Topcon TRC-NW400; 2212 by 1661 pixels; retinal fundus photograph; sex: F; 30° field of view; optic disc-centered.
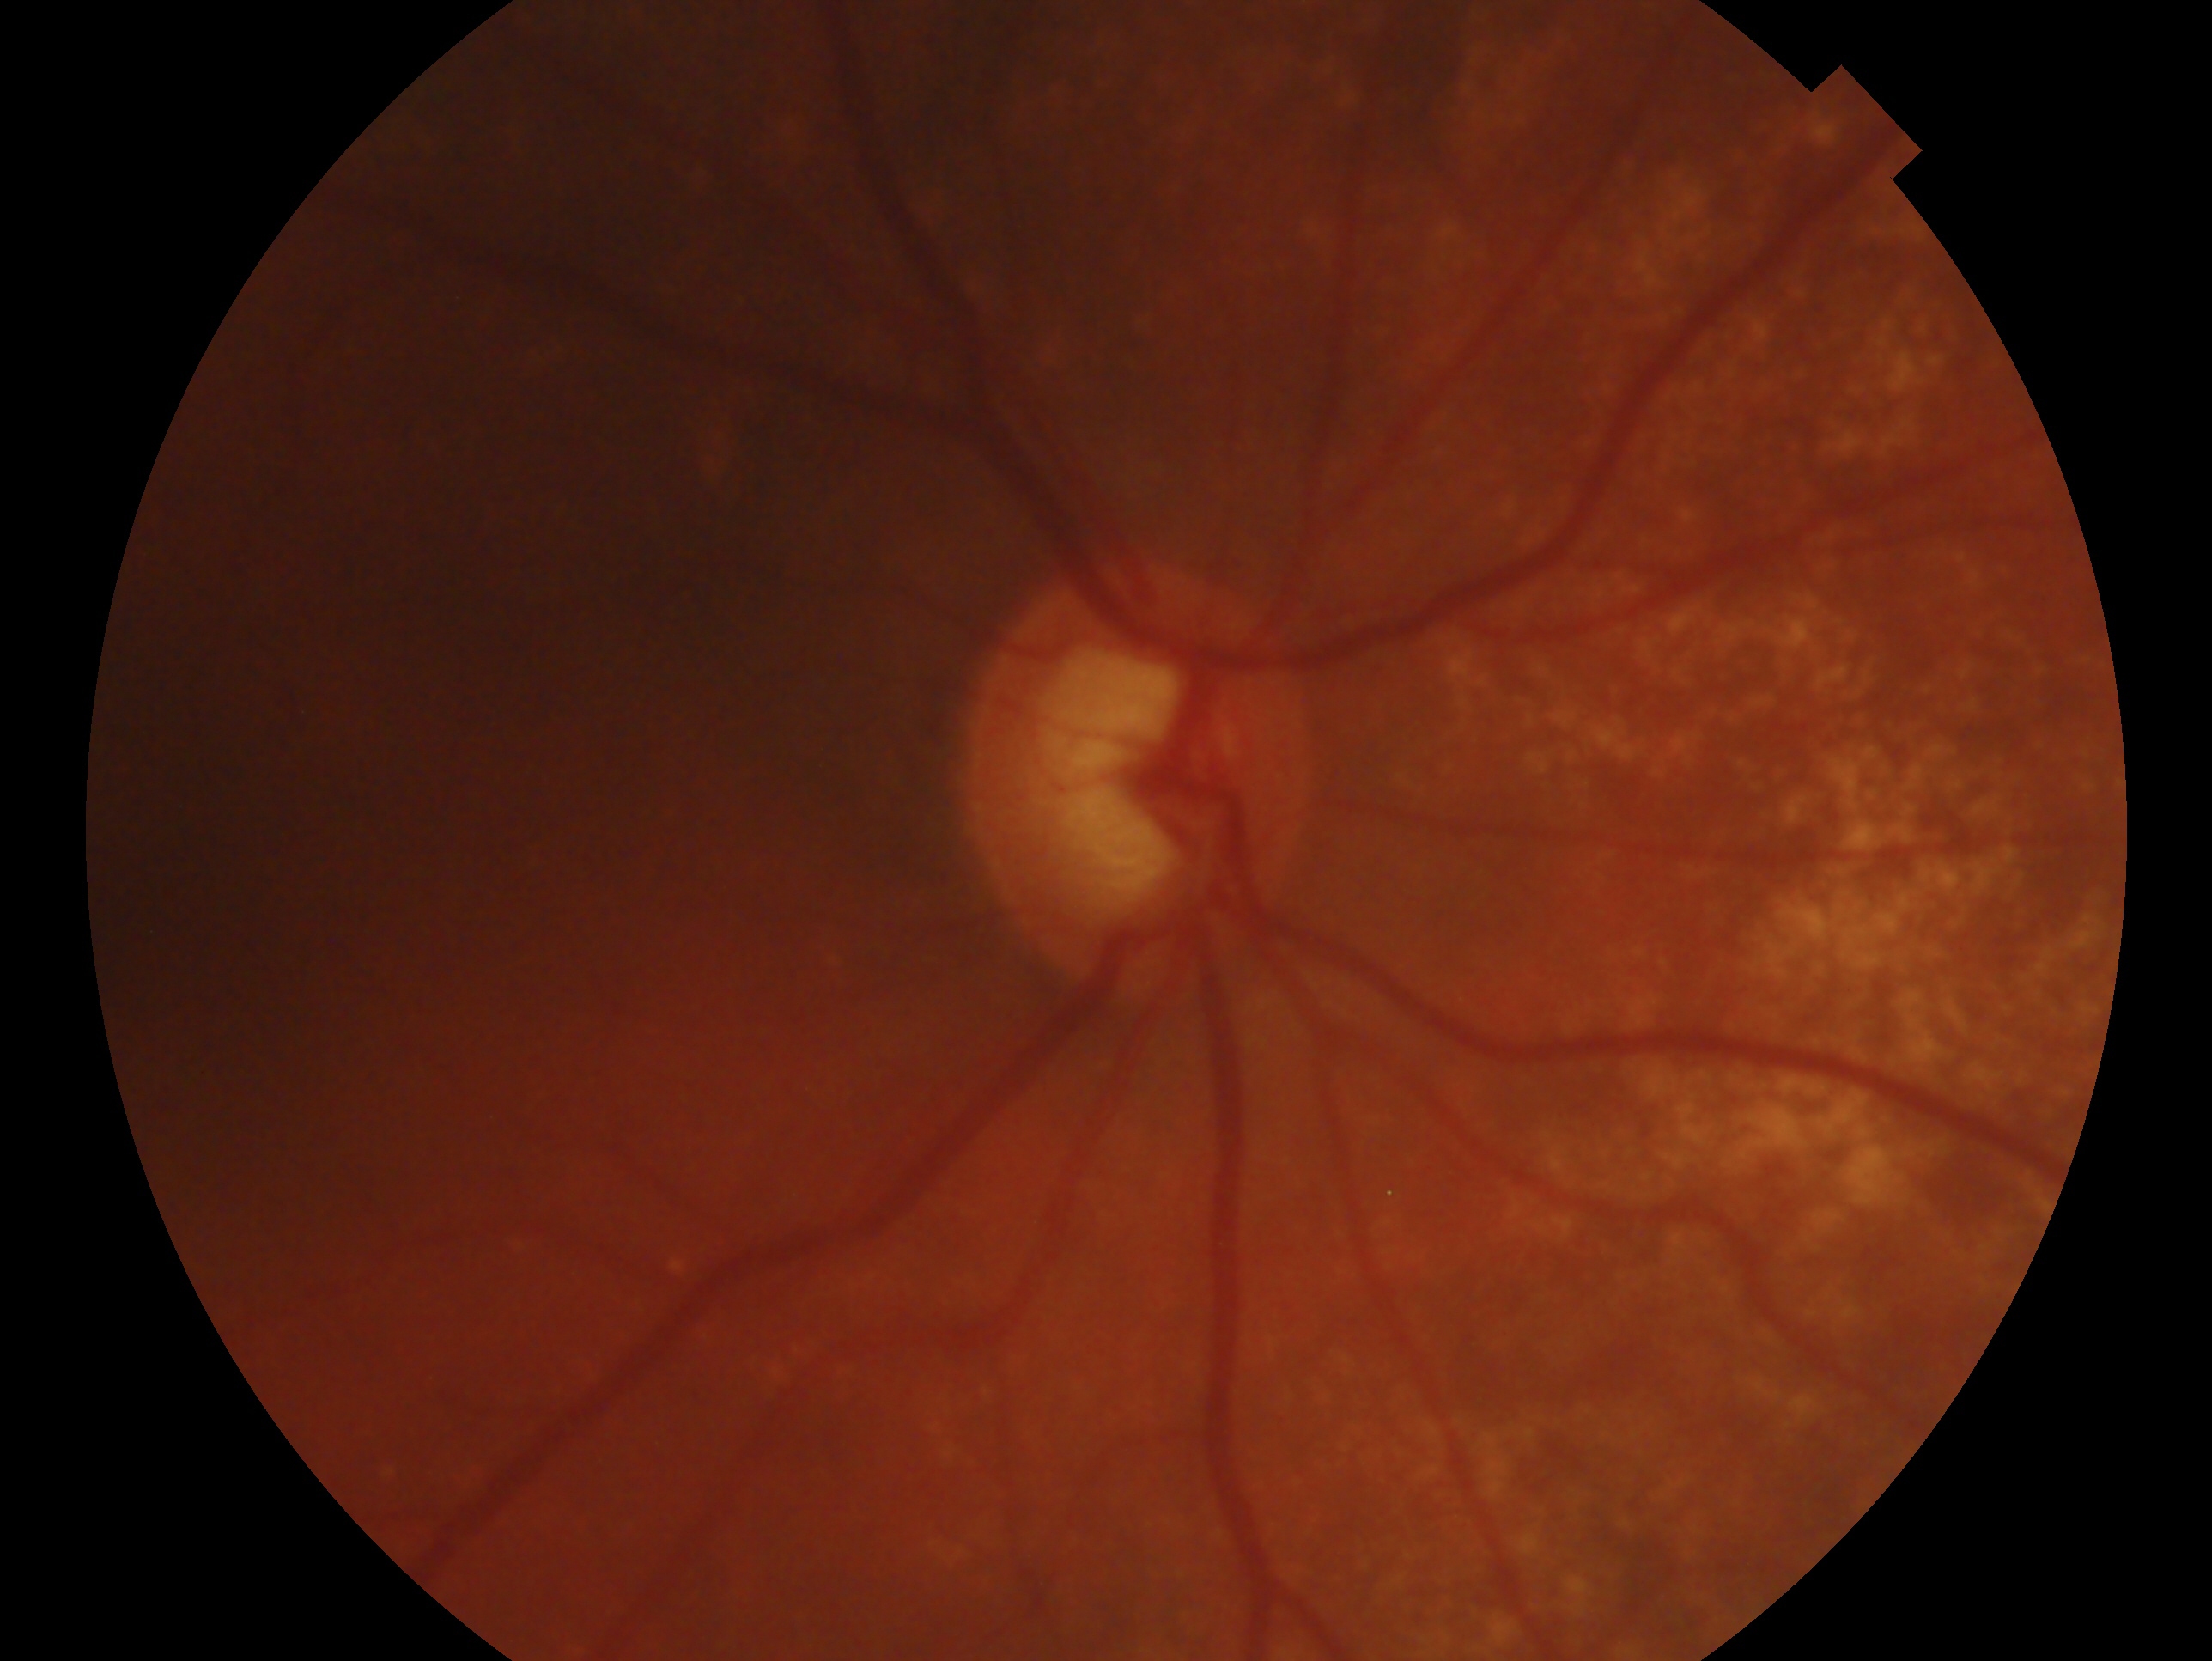 • impression: glaucoma — clinically confirmed glaucoma with characteristic optic nerve damage
• laterality: right eye